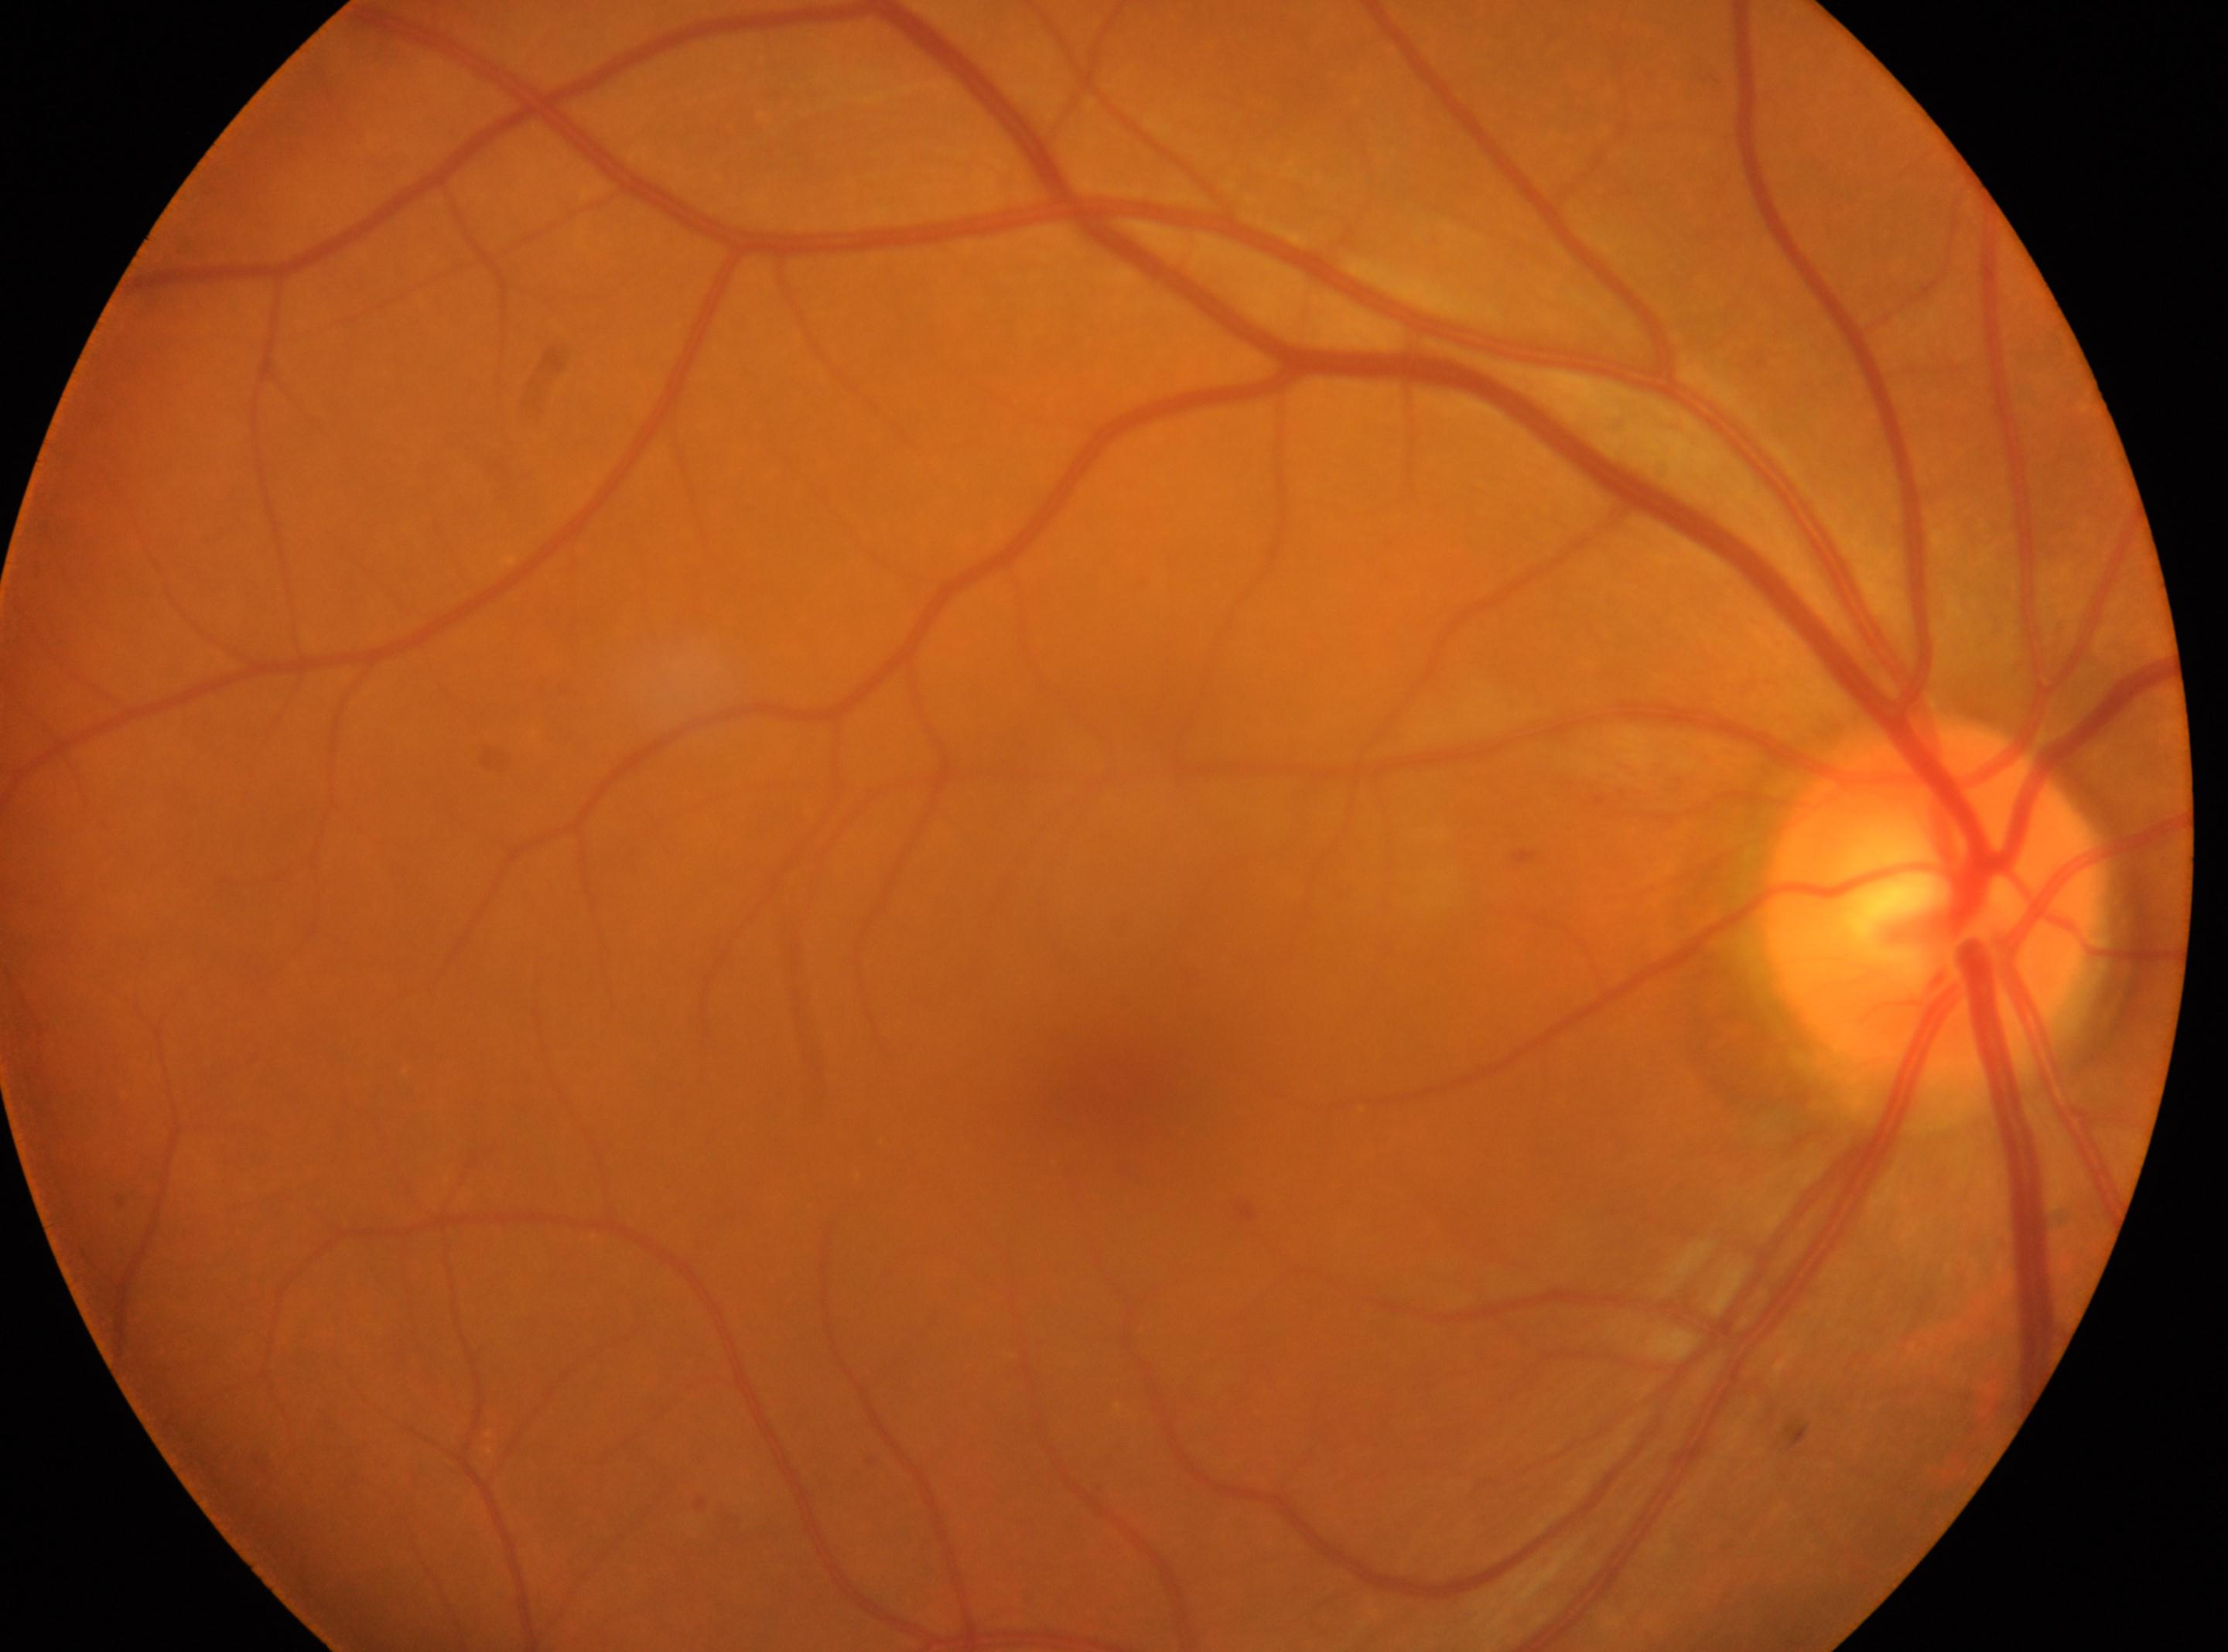

– laterality: oculus dexter
– fovea centralis: (x: 1114, y: 1083)
– DR stage: grade 1 (mild NPDR)
– the optic disc: (x: 1934, y: 899)